Color fundus photograph.
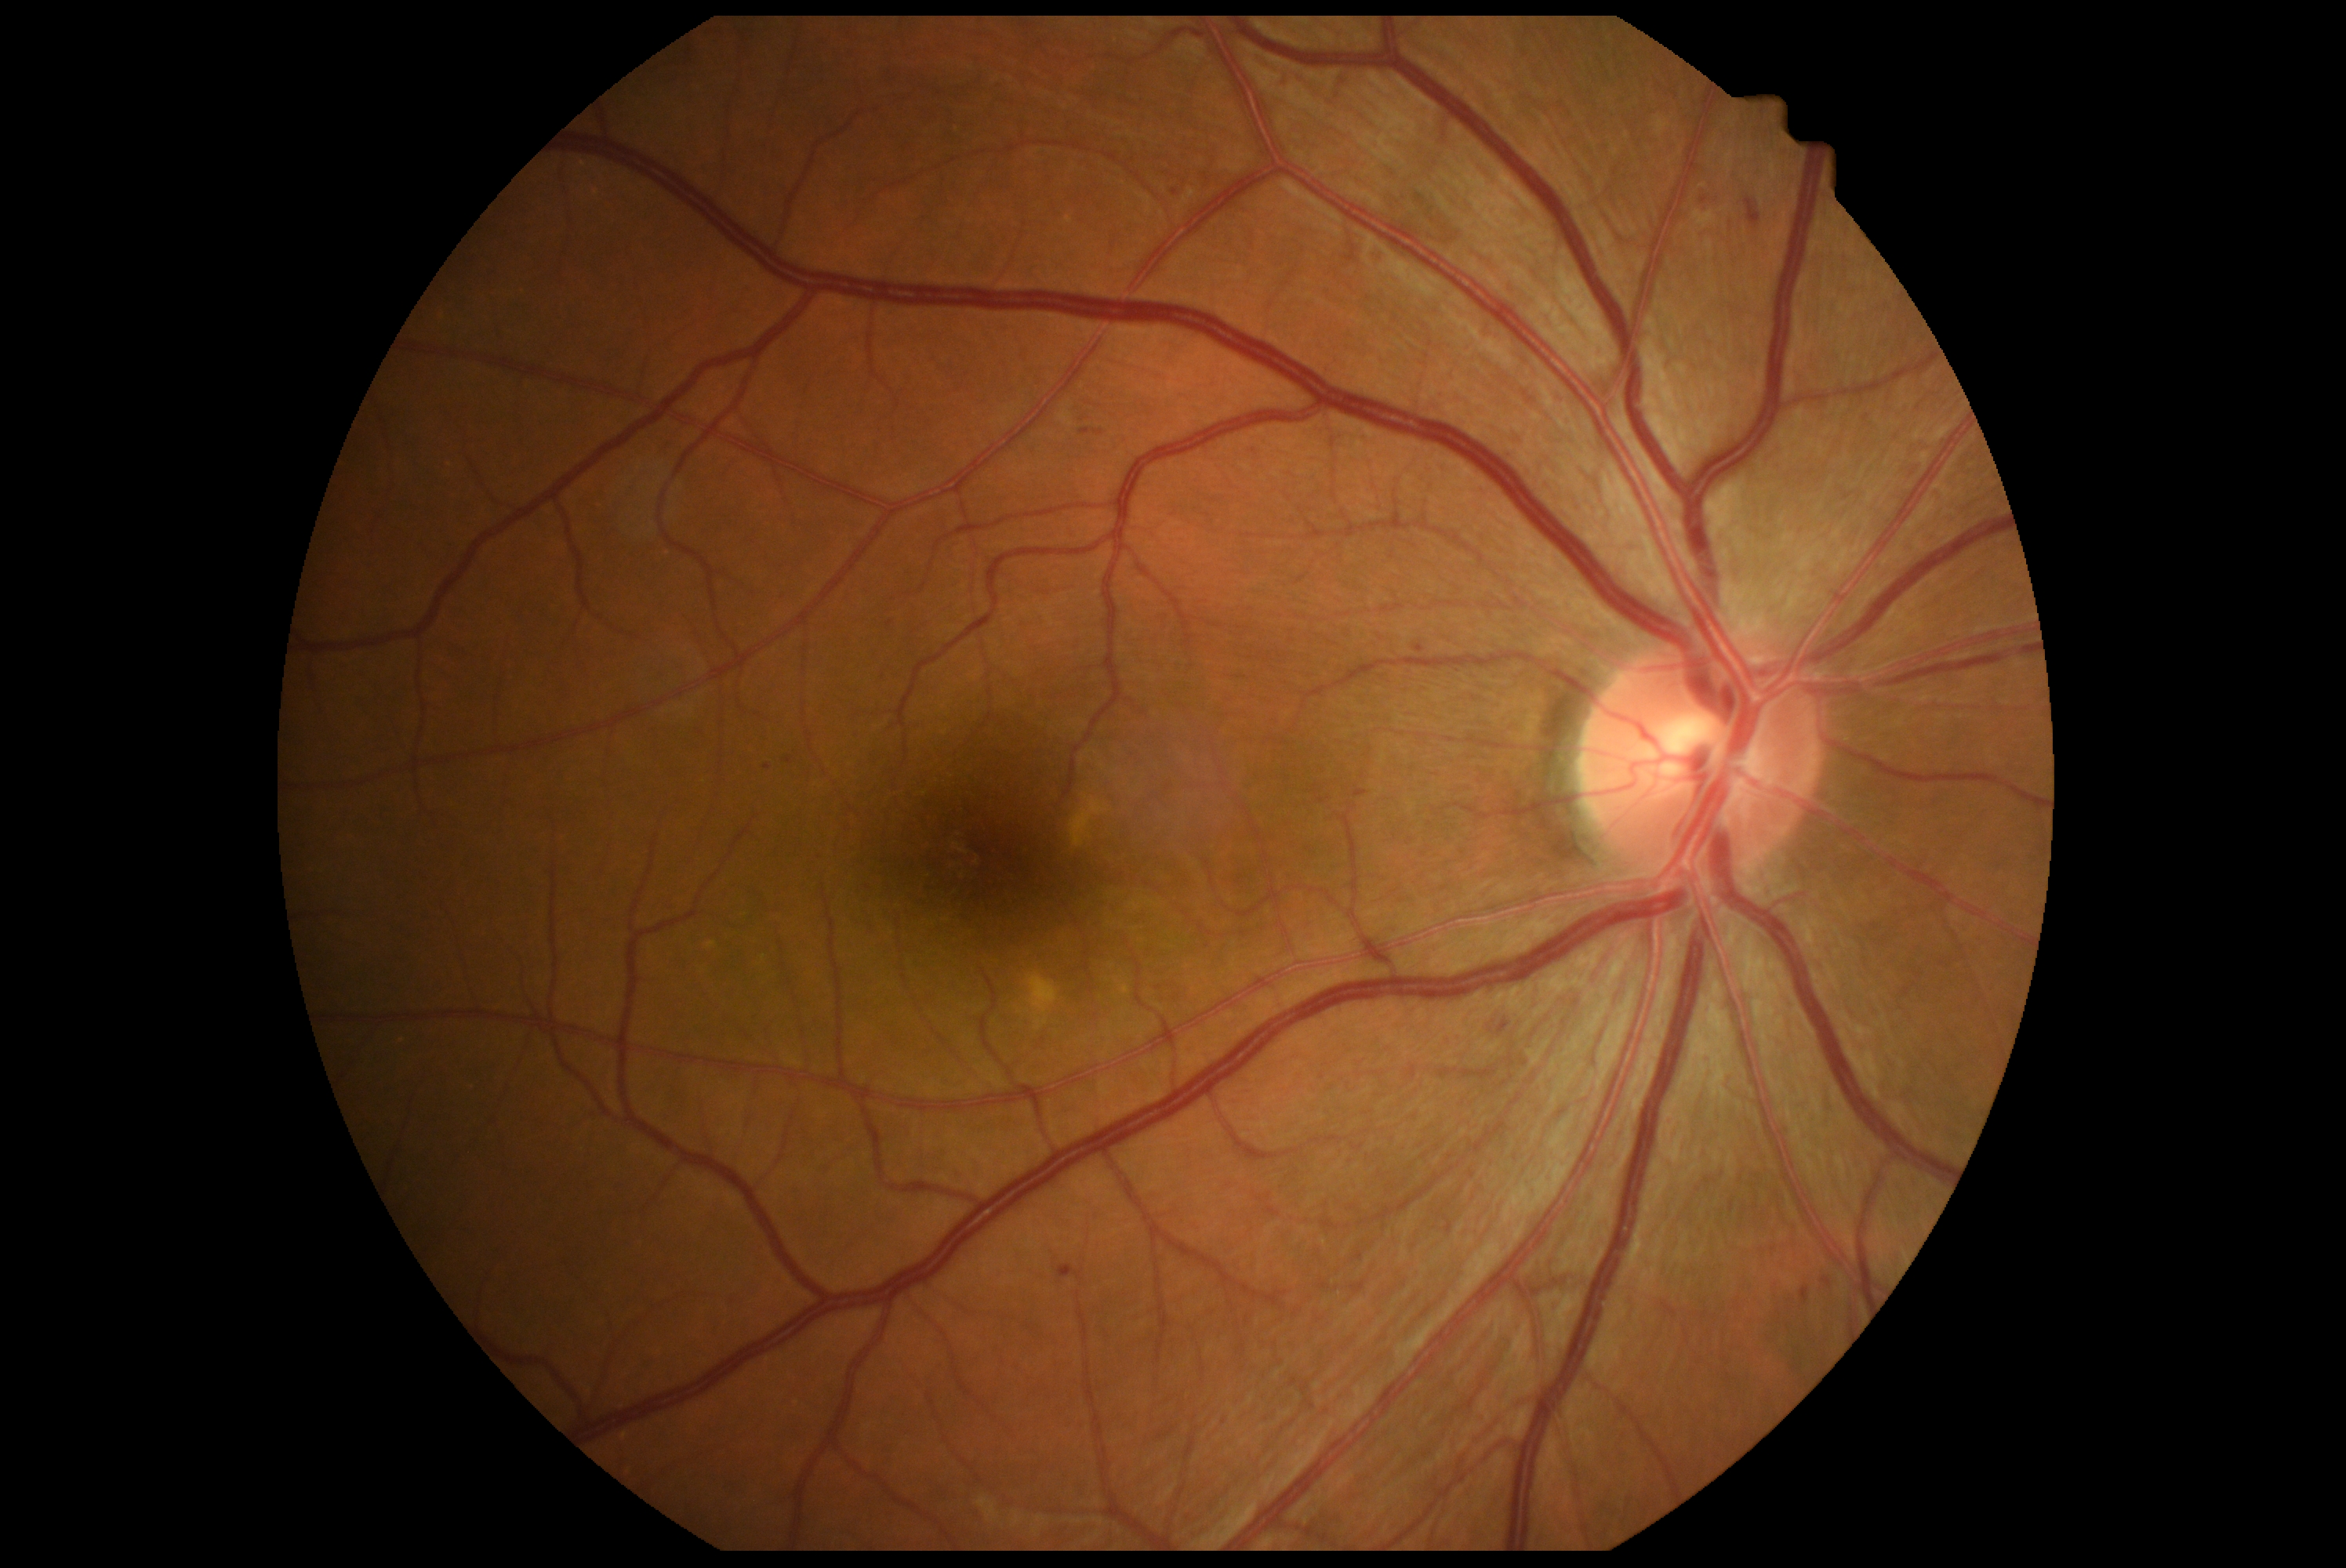
Diabetic retinopathy: grade 2 (moderate NPDR).